45-degree field of view · 2352 by 1568 pixels:
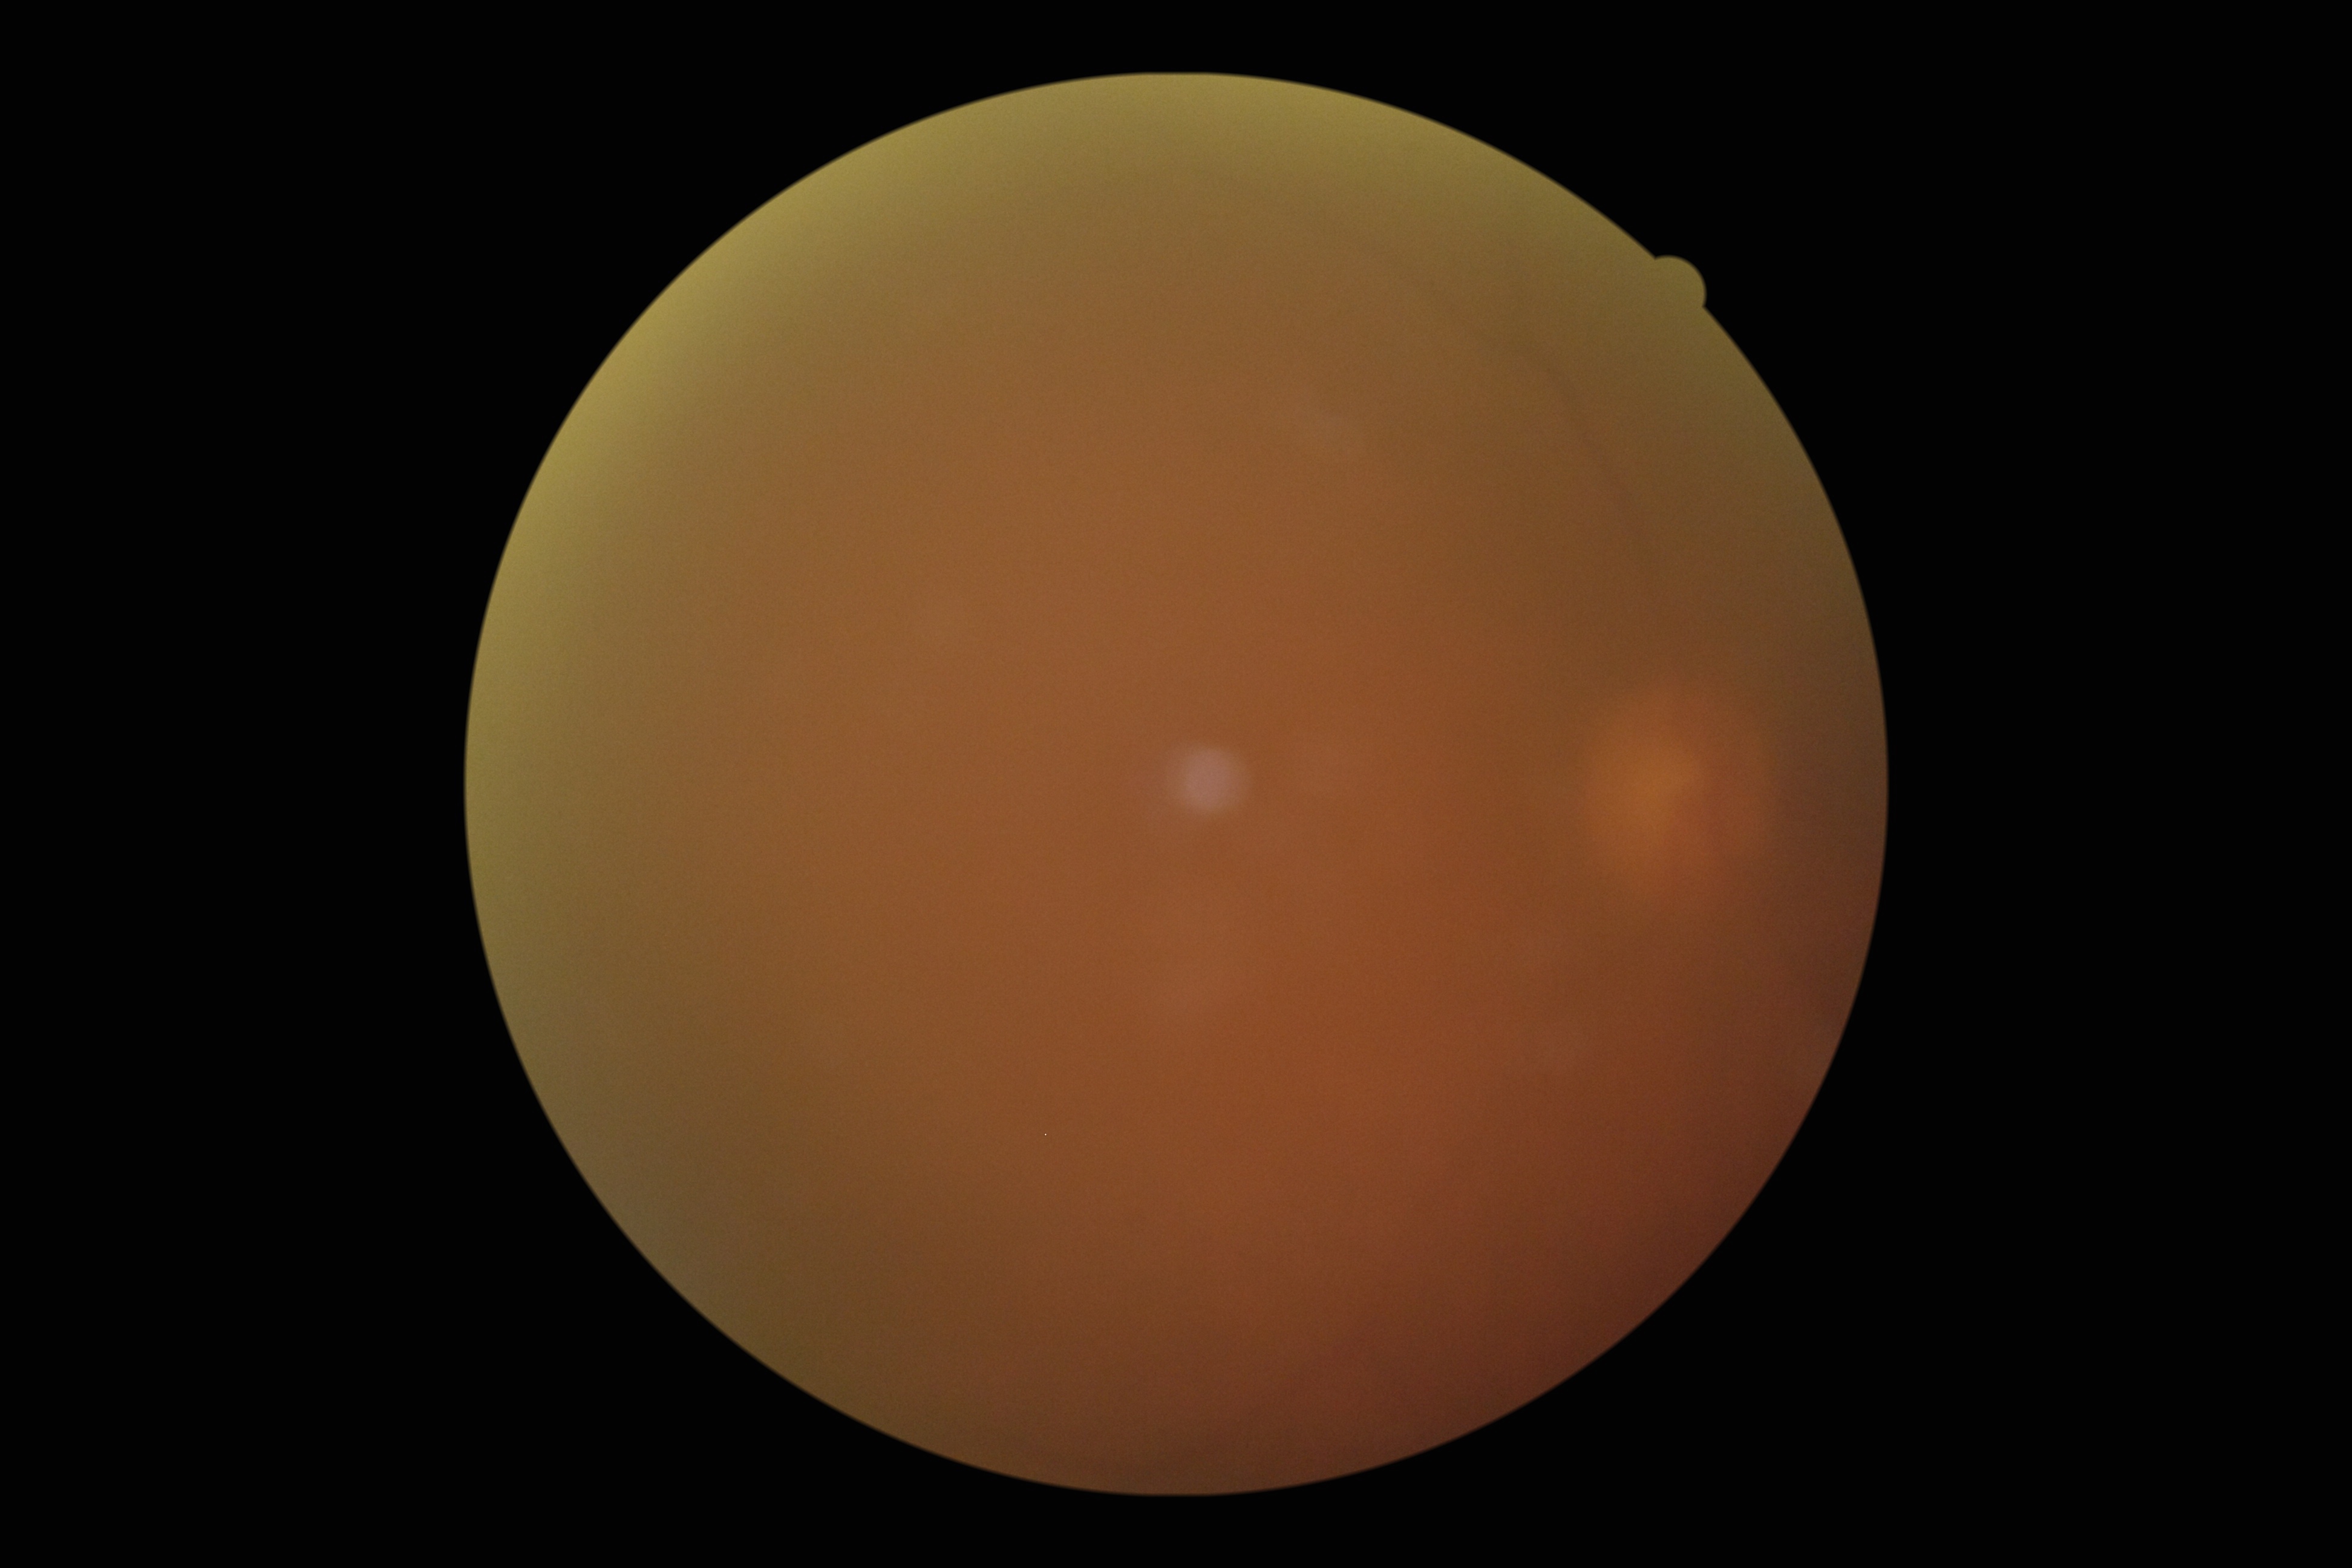

diabetic retinopathy (DR) = ungradable due to poor image quality.